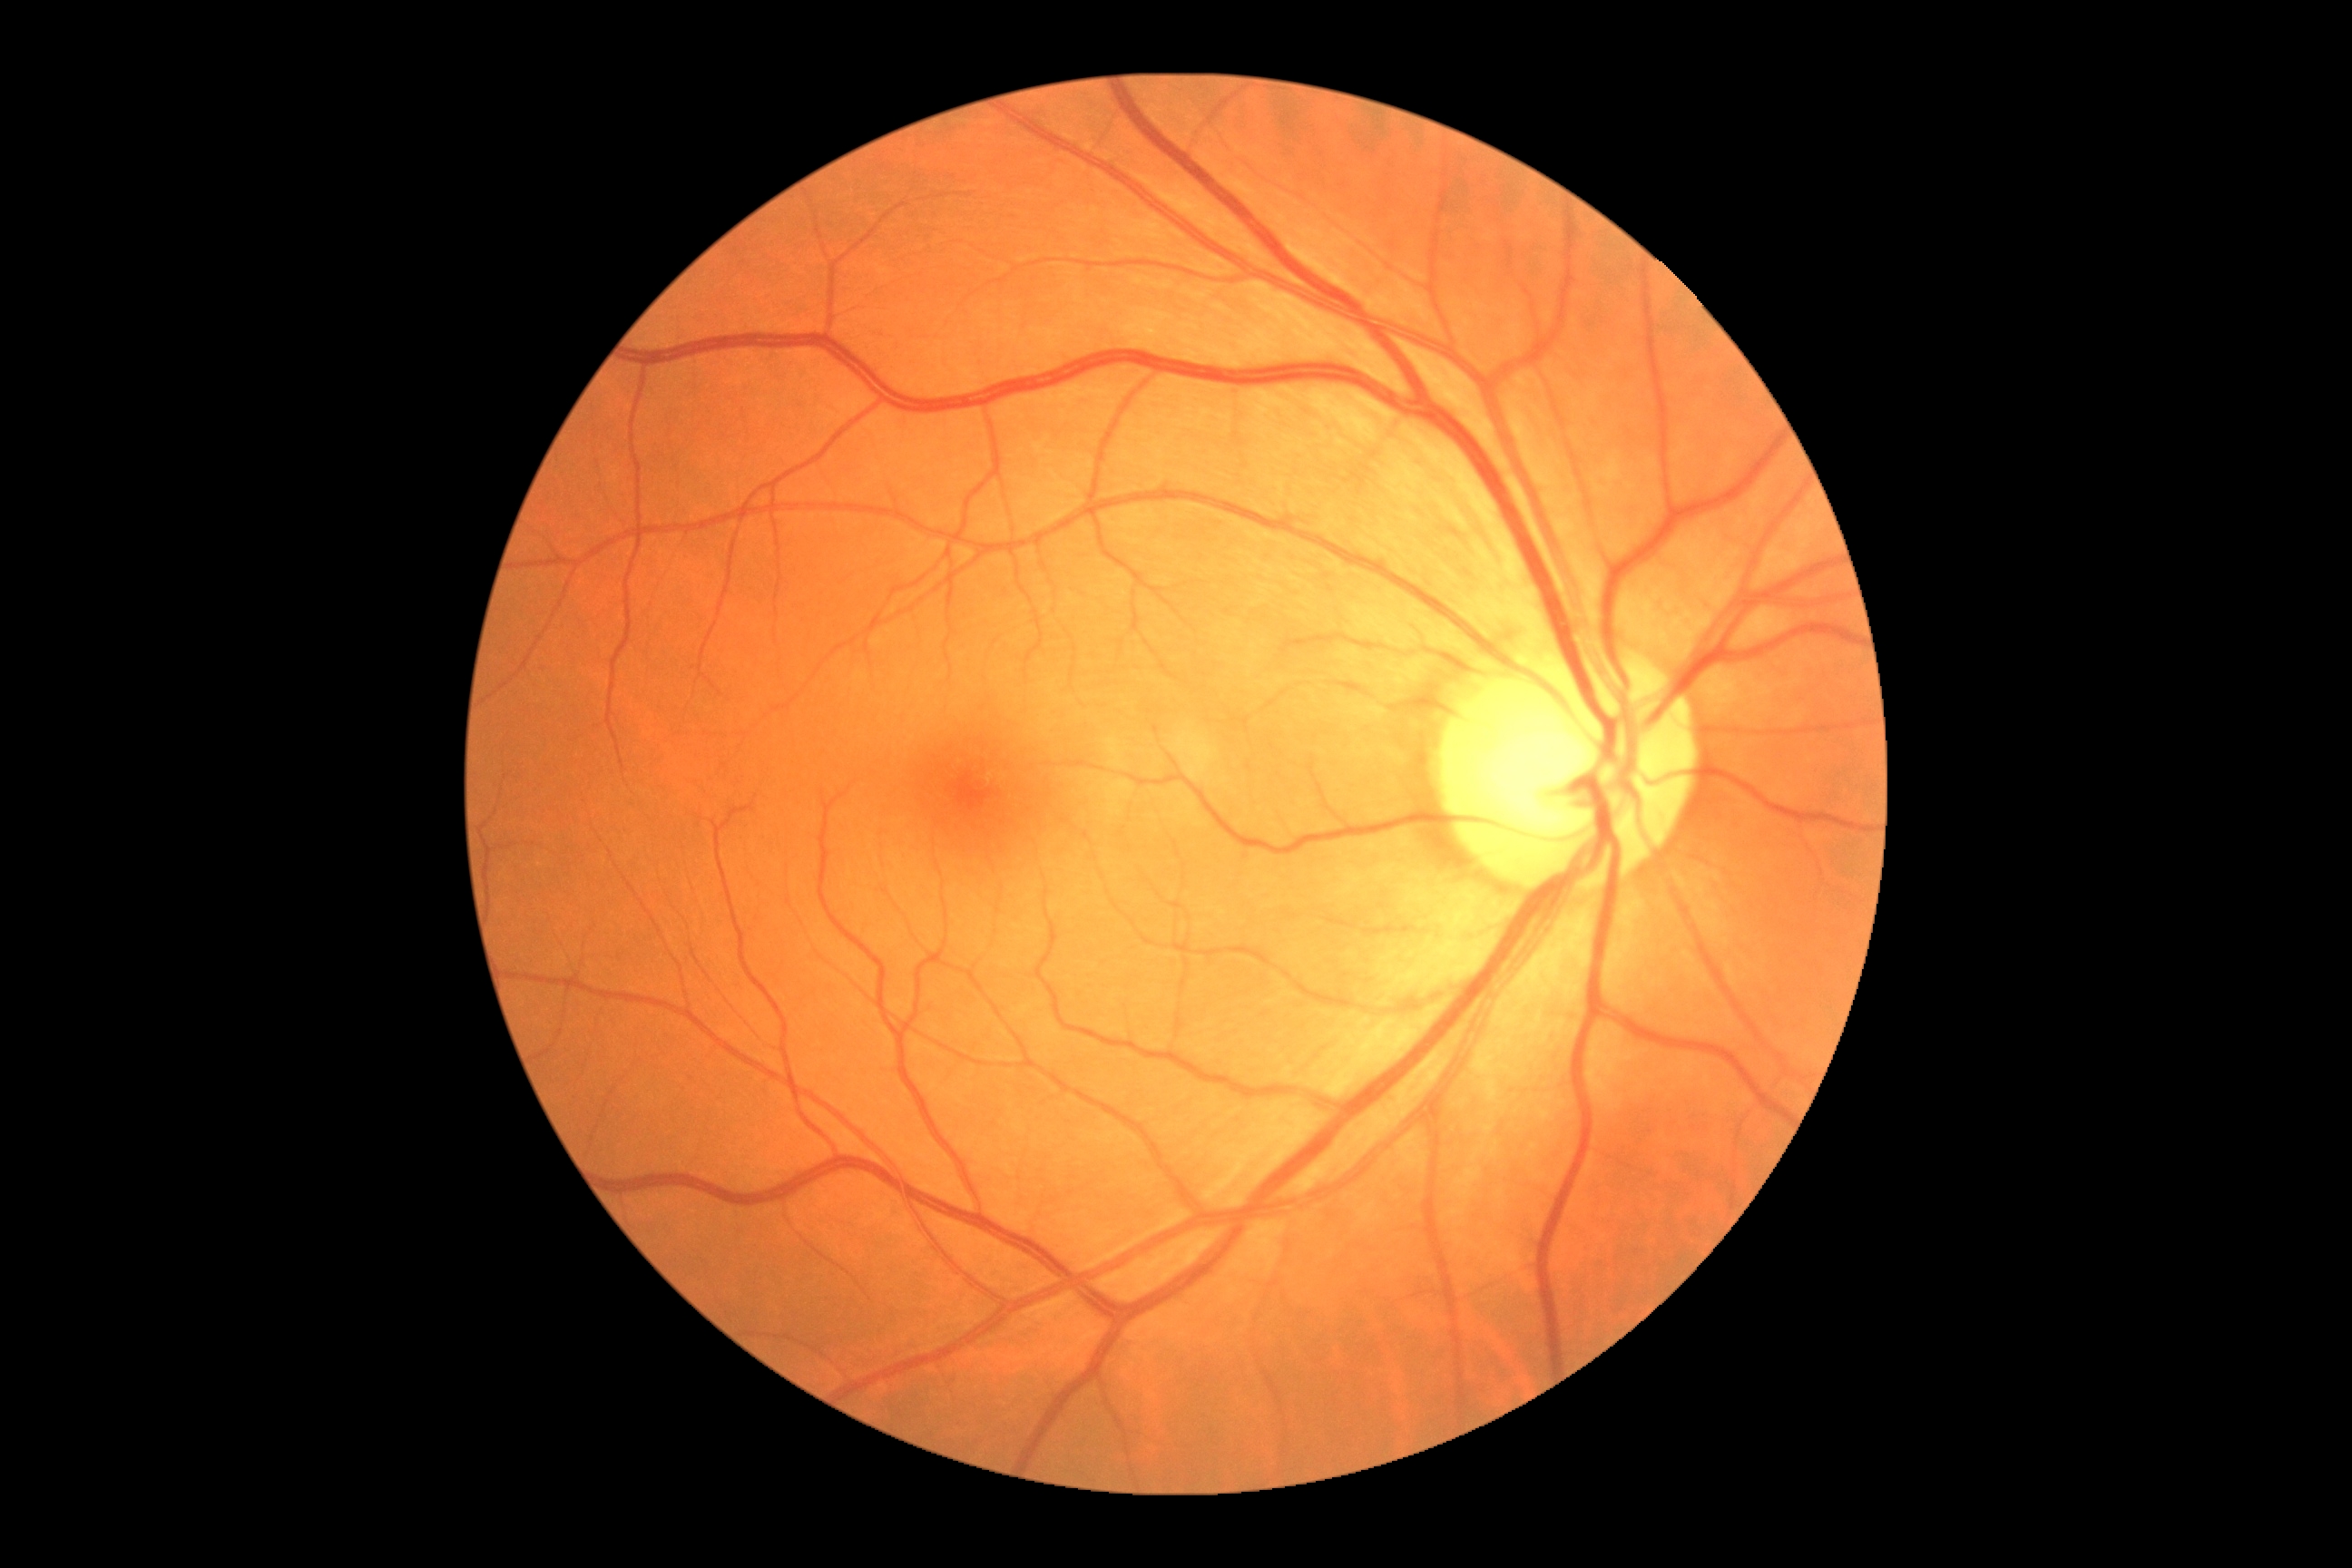 Annotations:
- DR stage — no apparent diabetic retinopathy (grade 0)